Camera: Phoenix ICON (100° FOV); infant wide-field fundus photograph; 1240x1240.
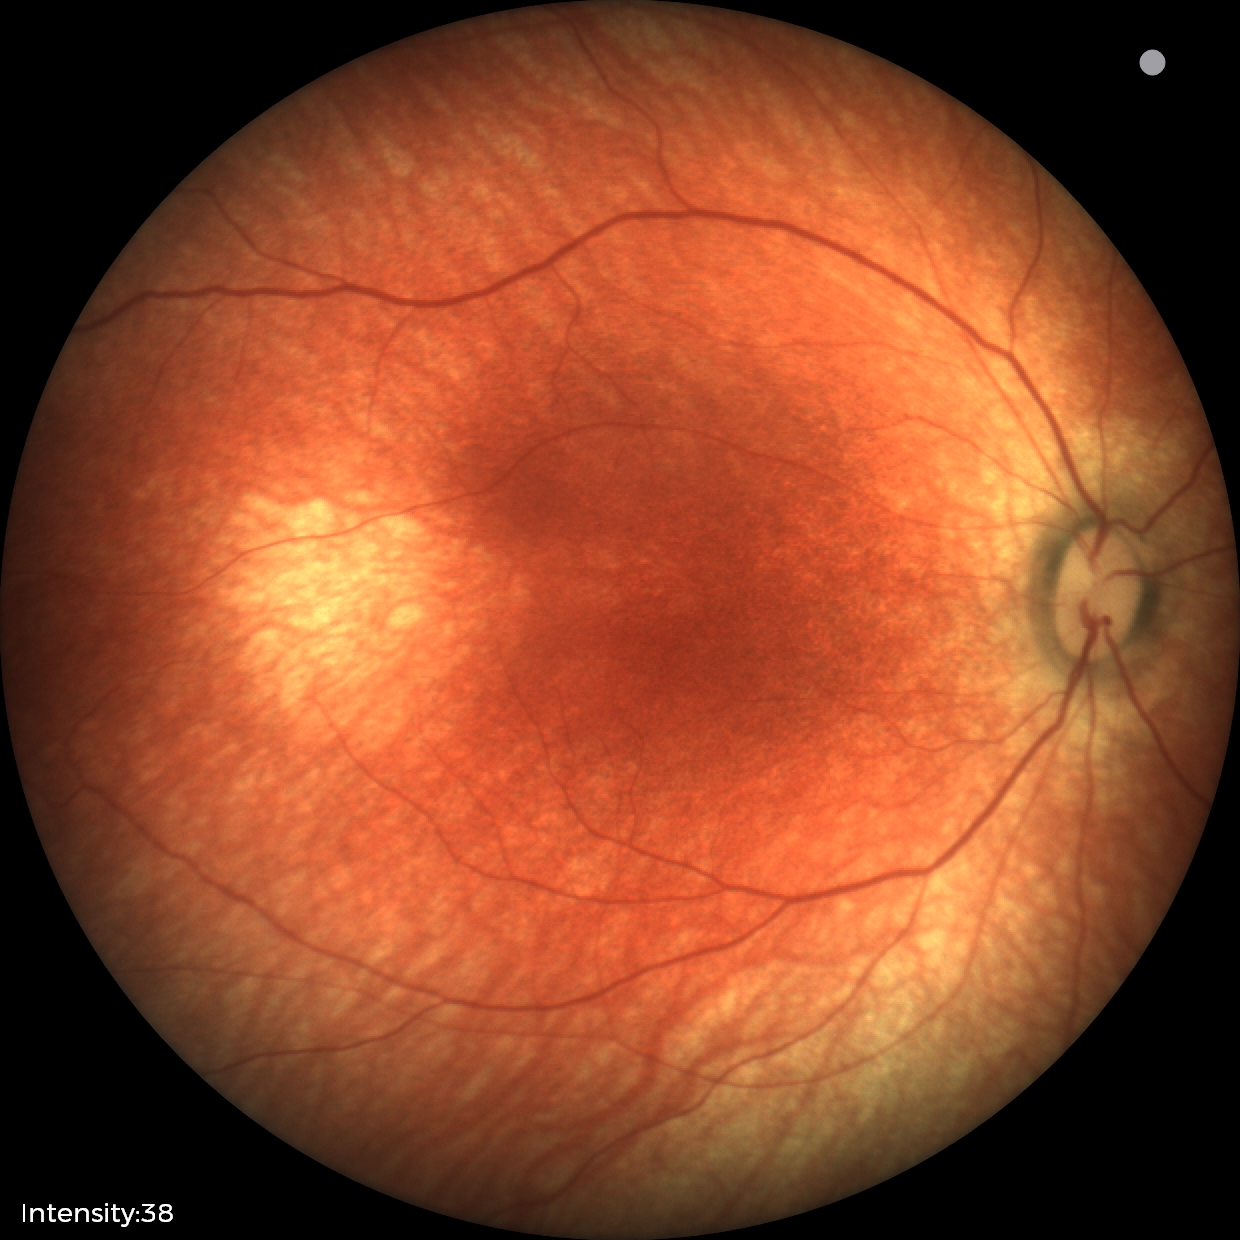

Q: What was the screening finding?
A: no abnormal retinal findings